2352 x 1568 pixels.
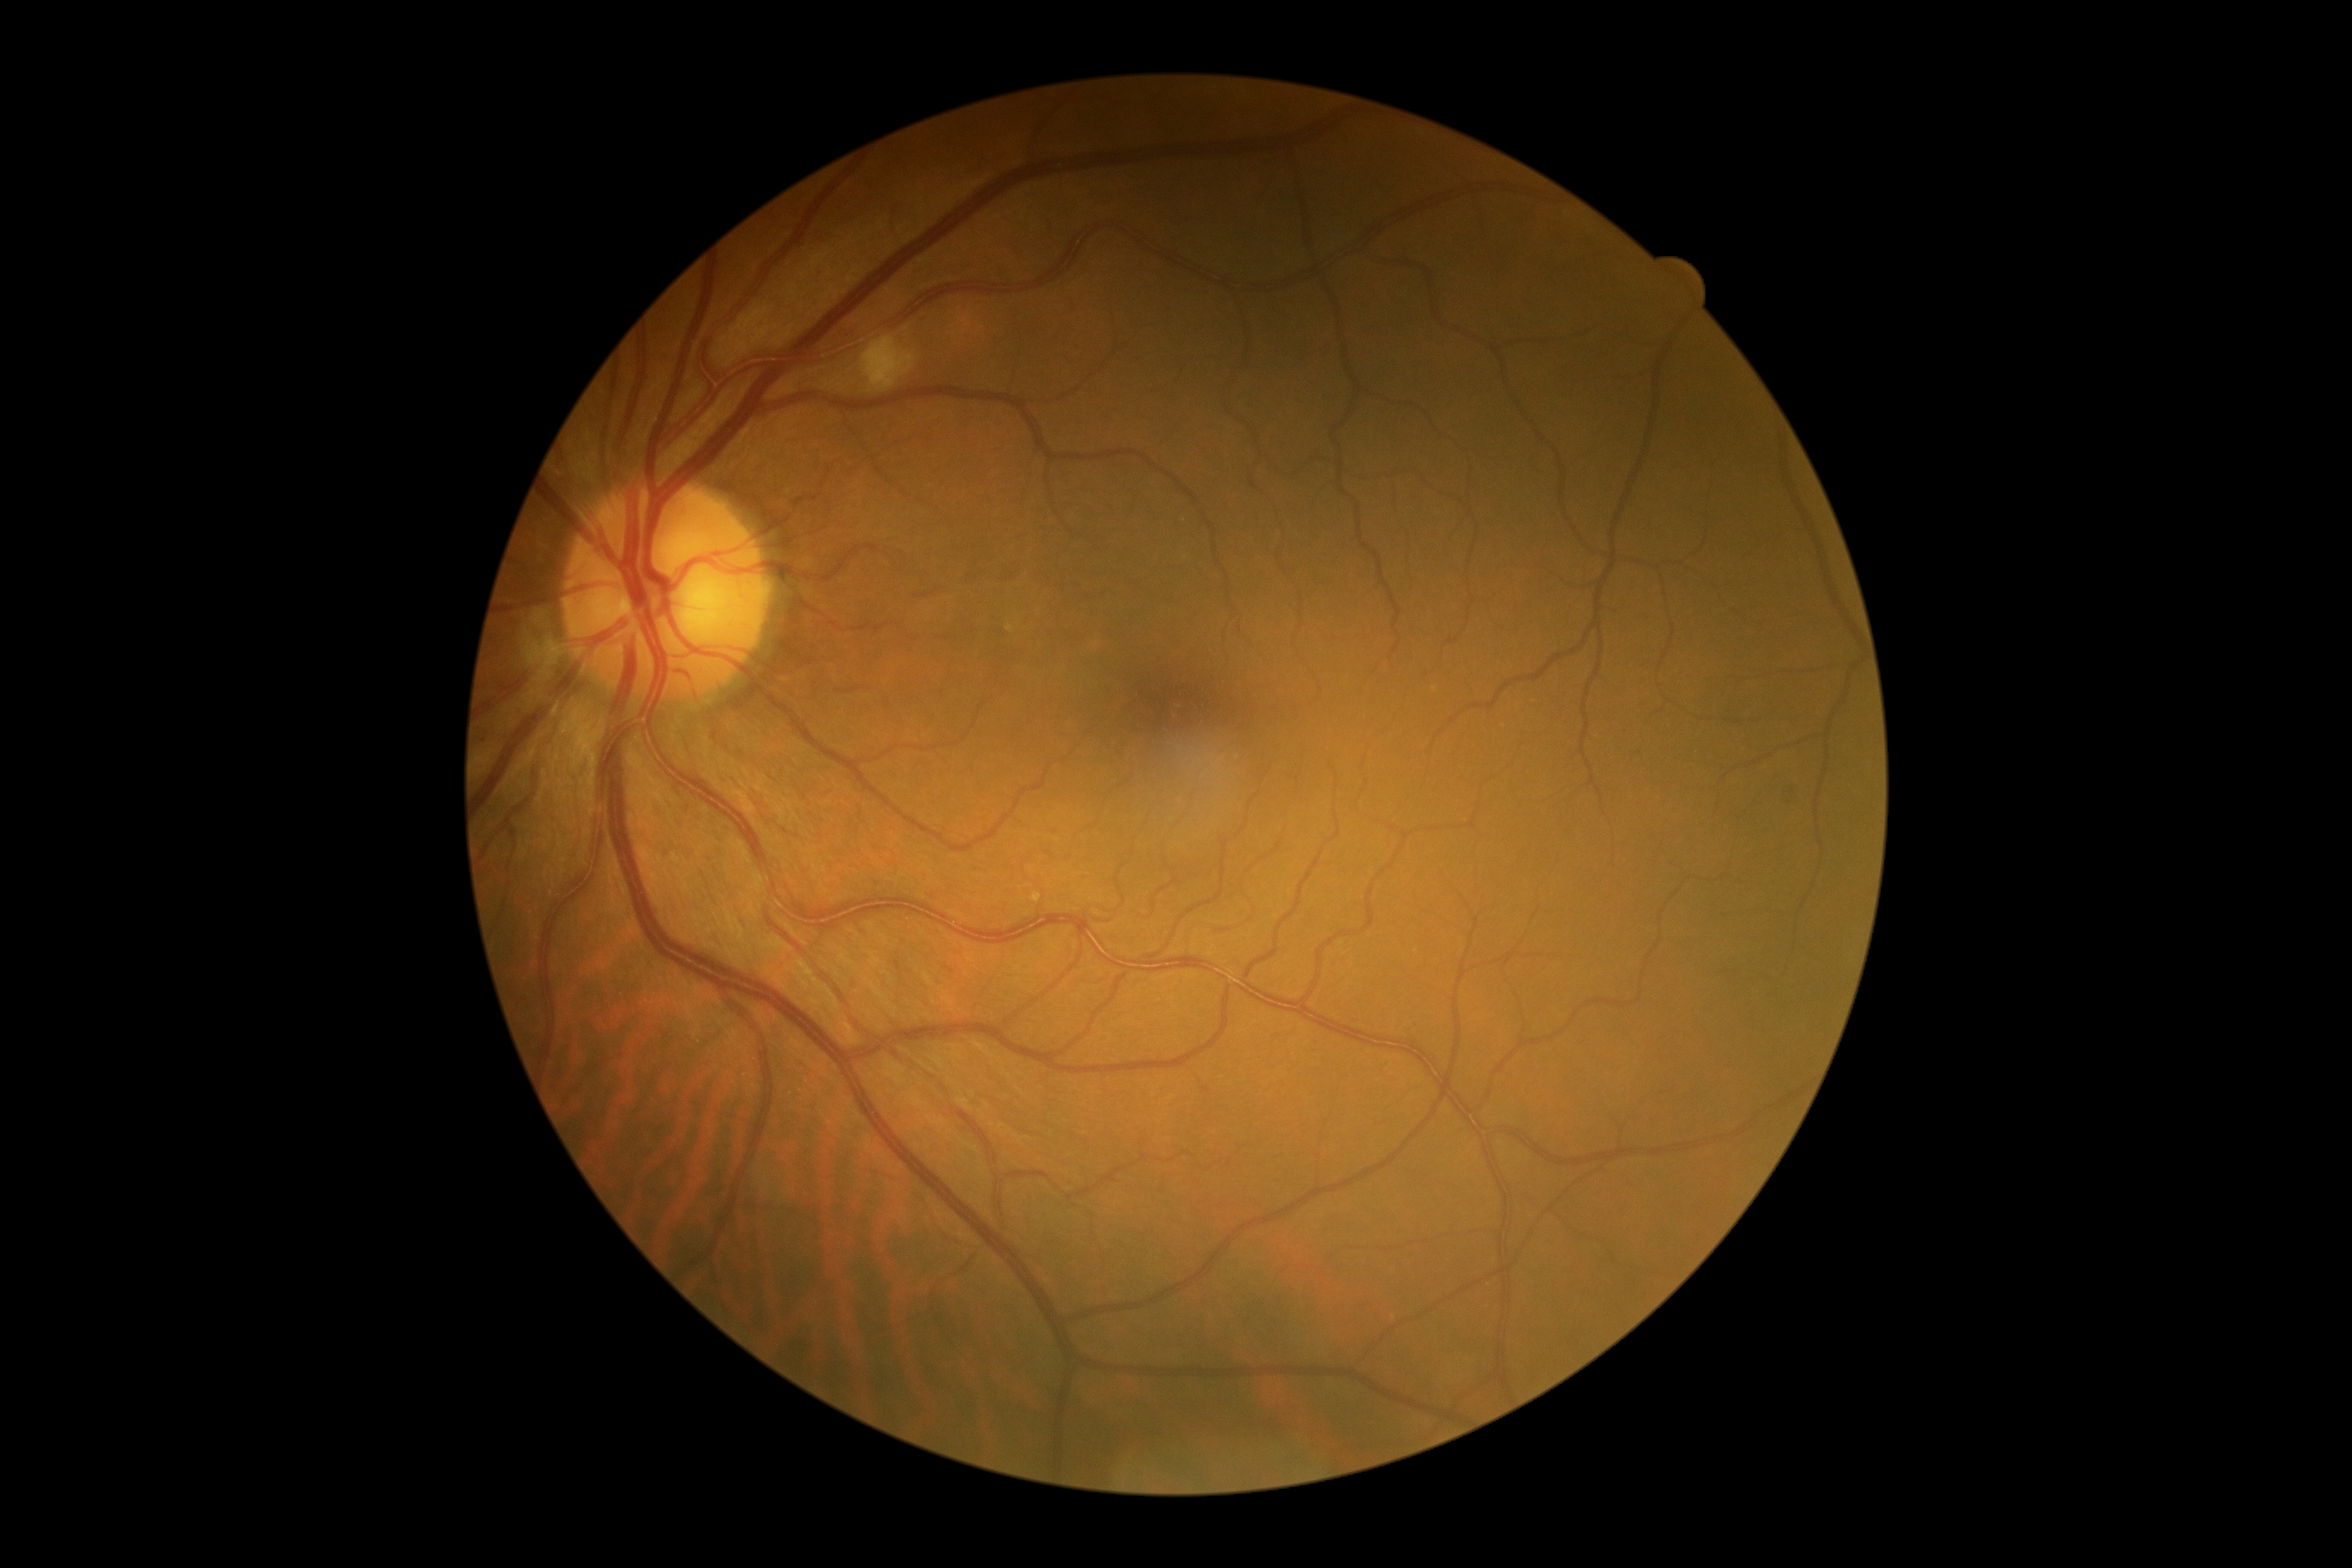

DR severity is moderate NPDR (grade 2).